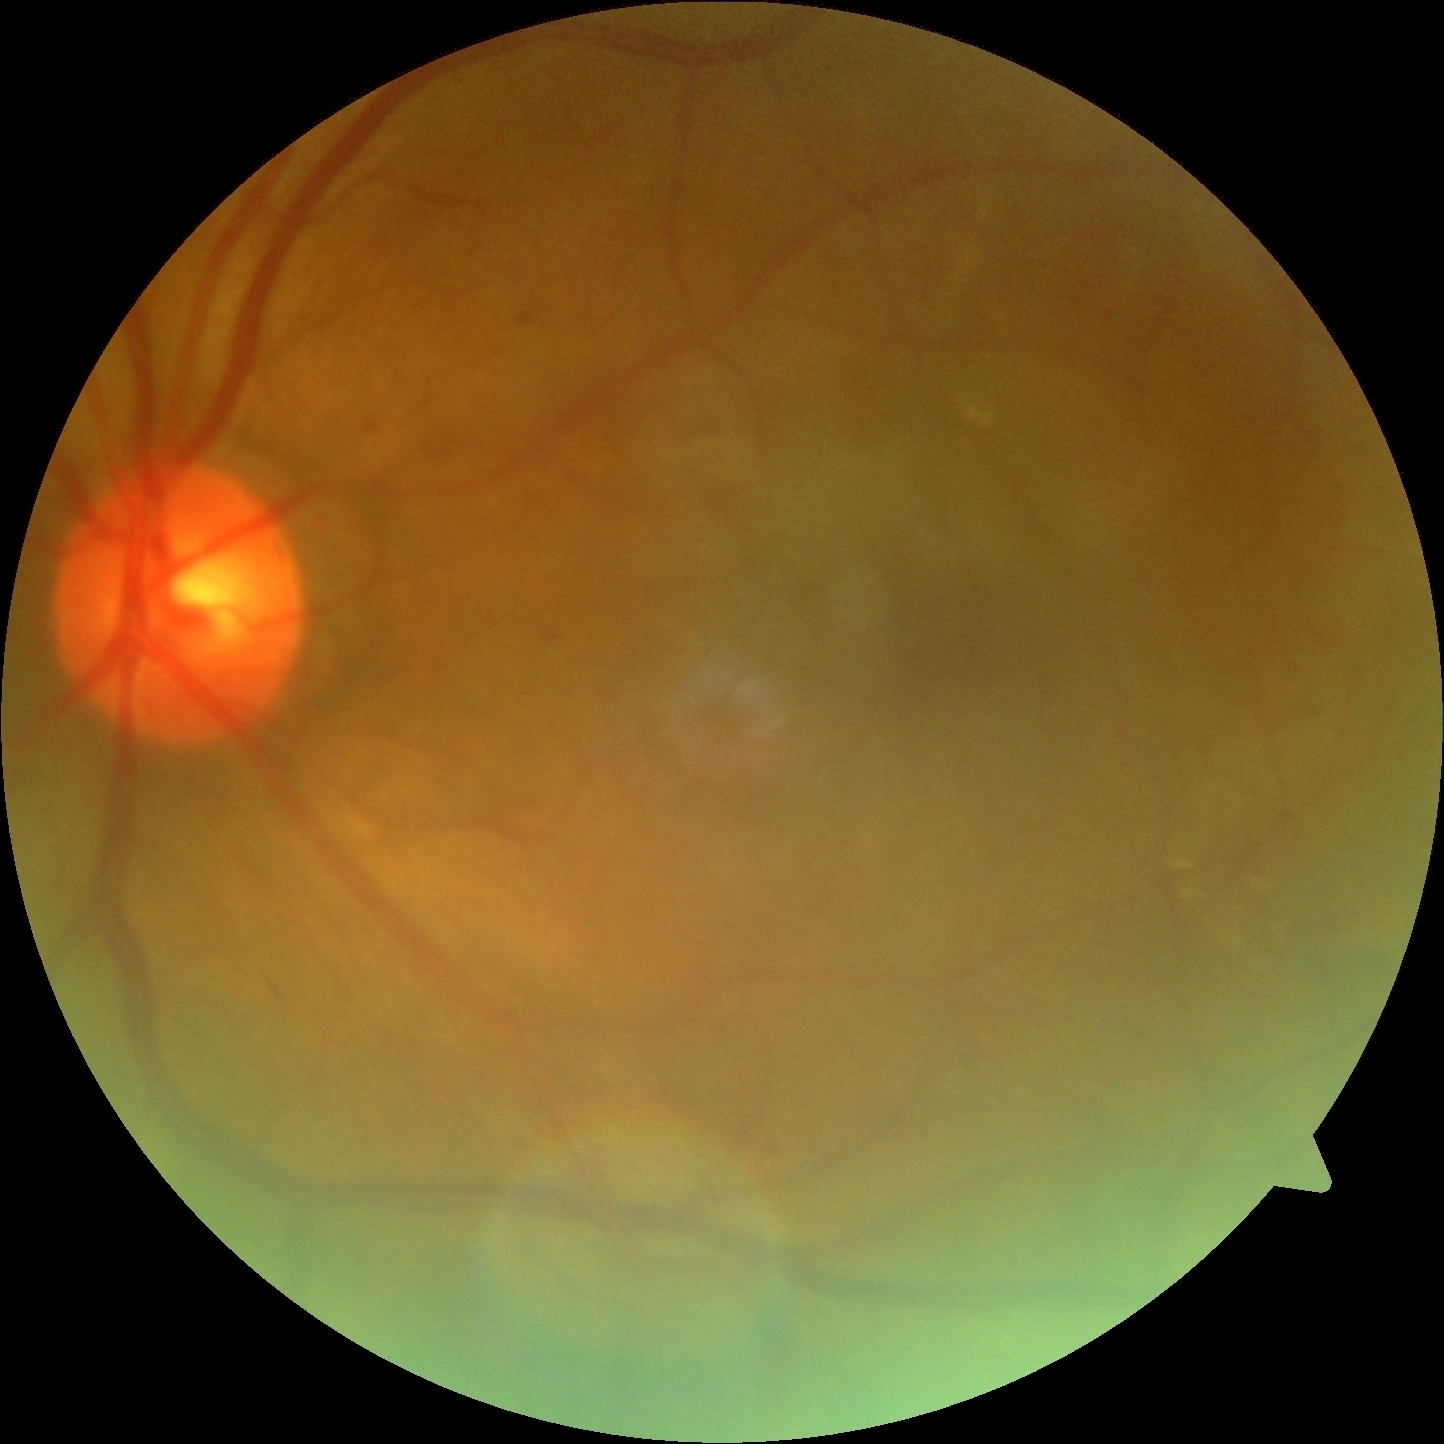 DR stage=2.